848x848 · NIDEK AFC-230 fundus camera · retinal fundus photograph.
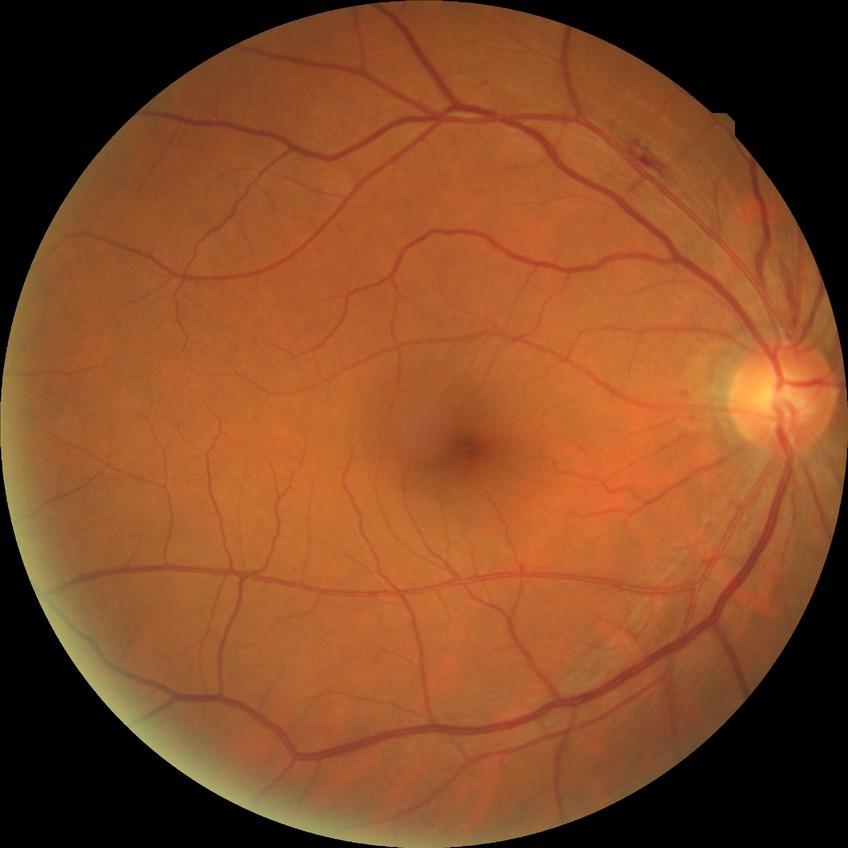

Diabetic retinopathy grade is no diabetic retinopathy.